2352x1568. Color fundus photograph: 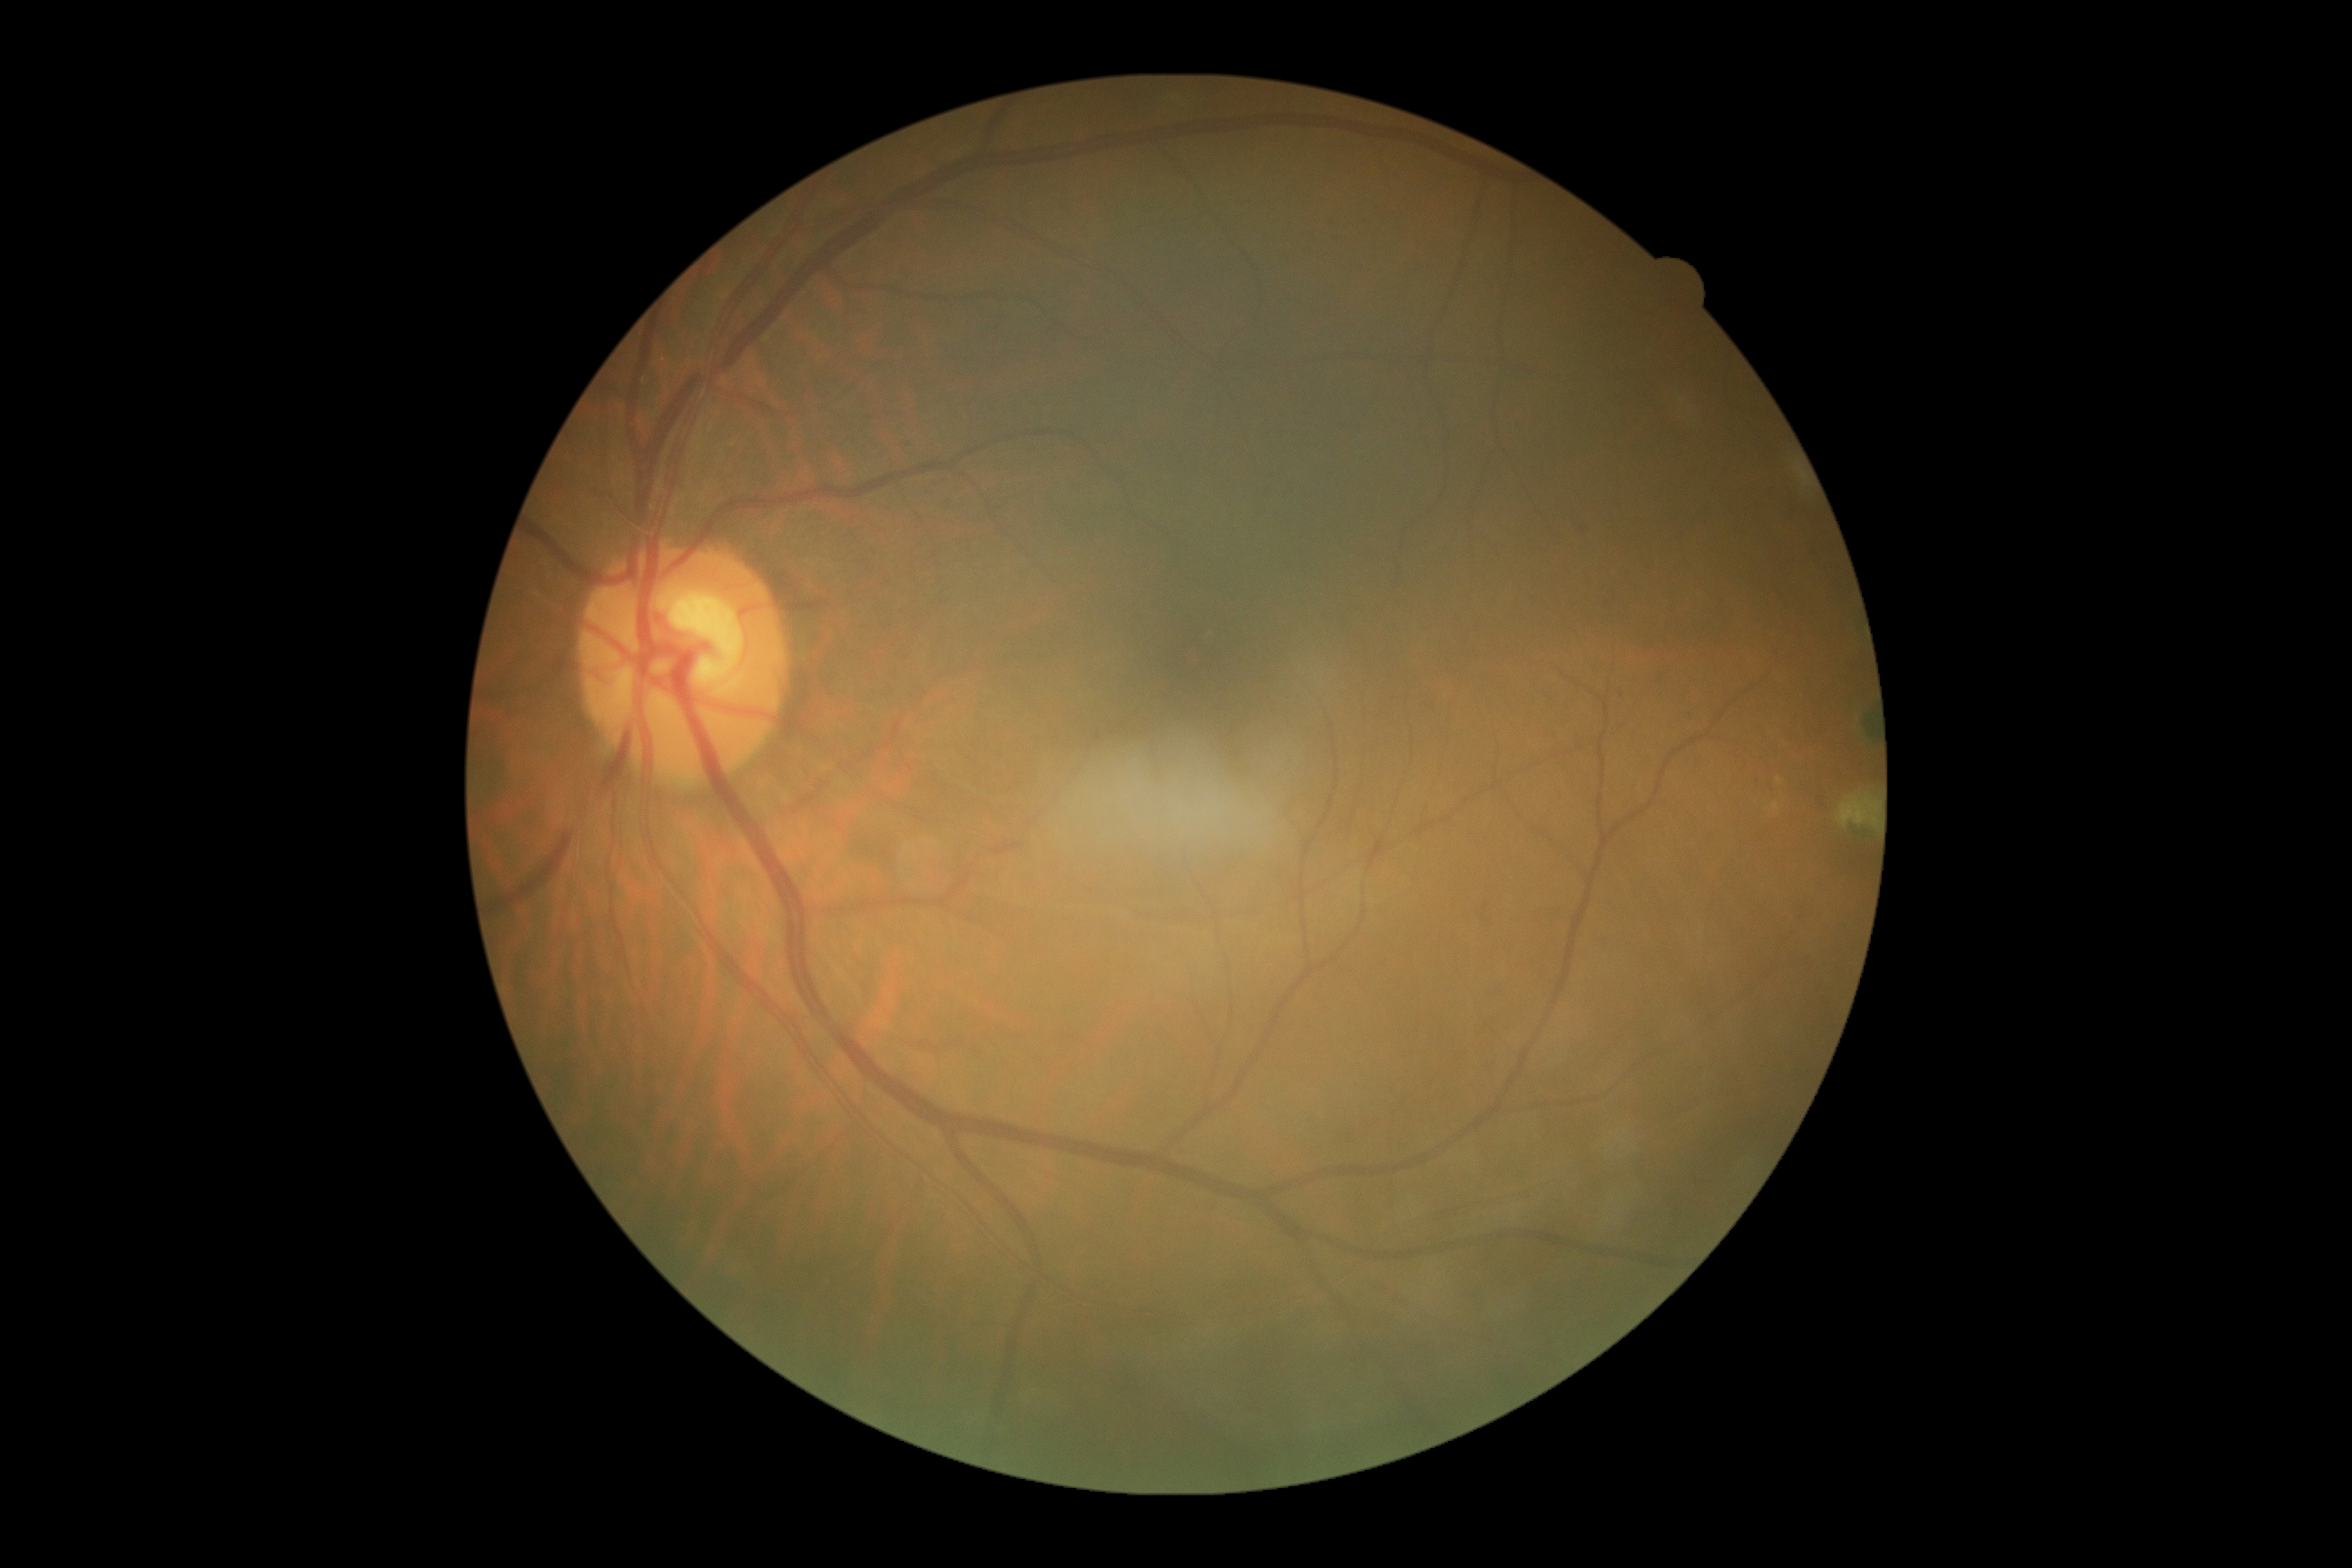 DR impression: negative for DR; DR grade: 0 (no apparent retinopathy).